1440 x 1080 pixels · wide-field fundus photograph from neonatal ROP screening: 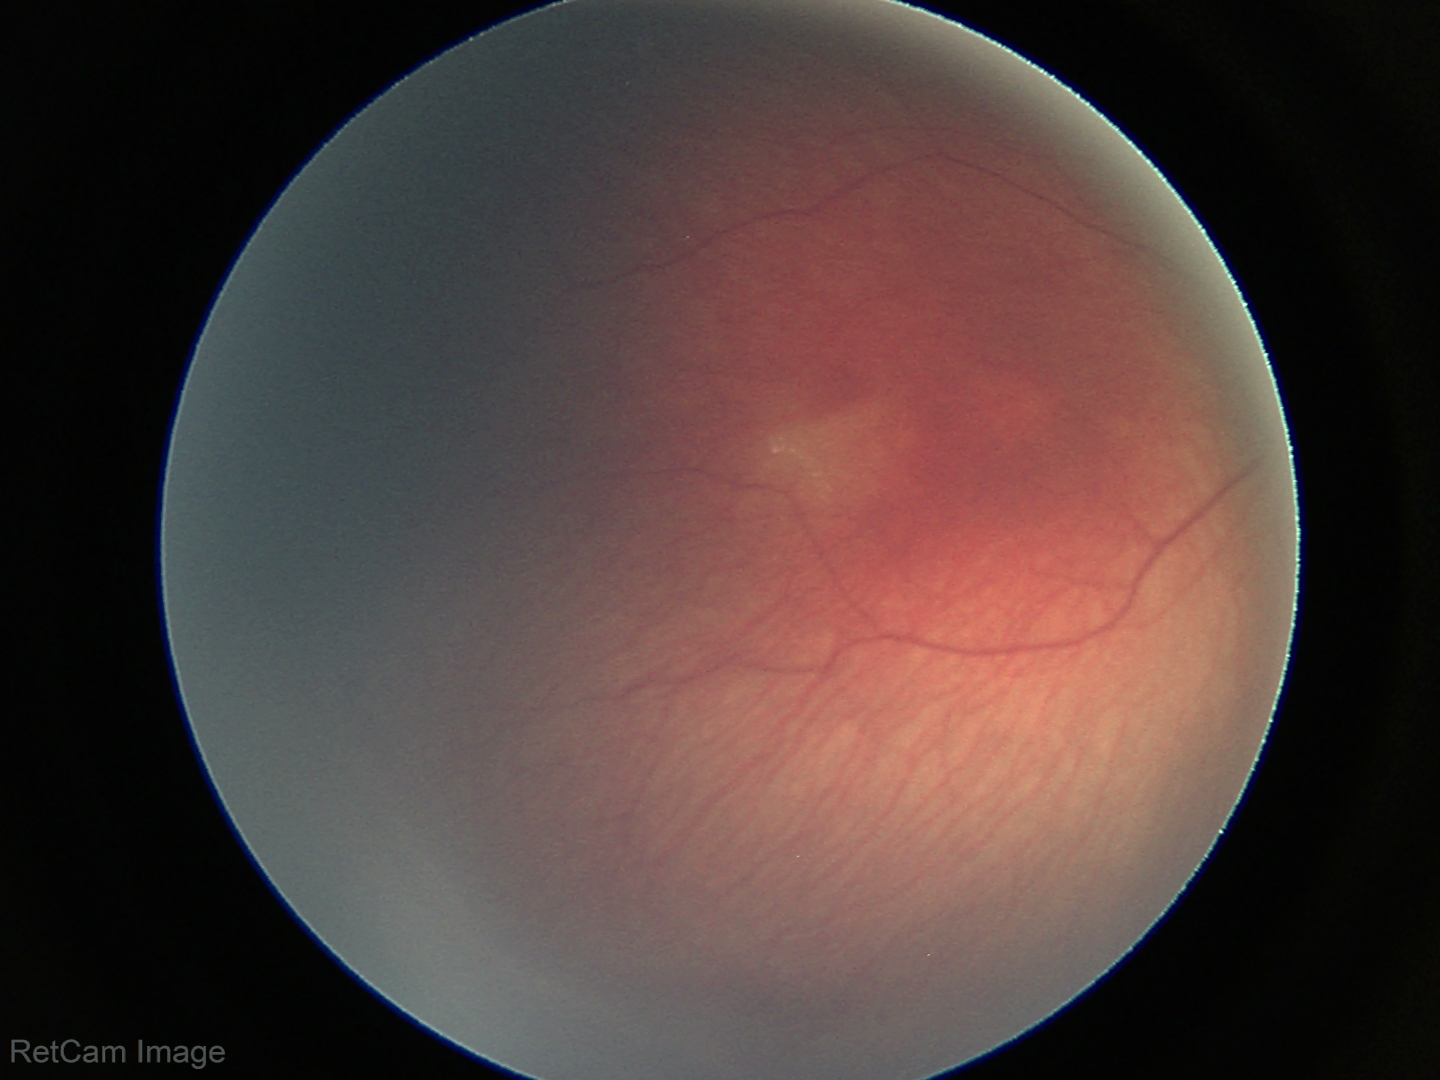
From an examination with diagnosis of ROP stage 2. No plus disease.